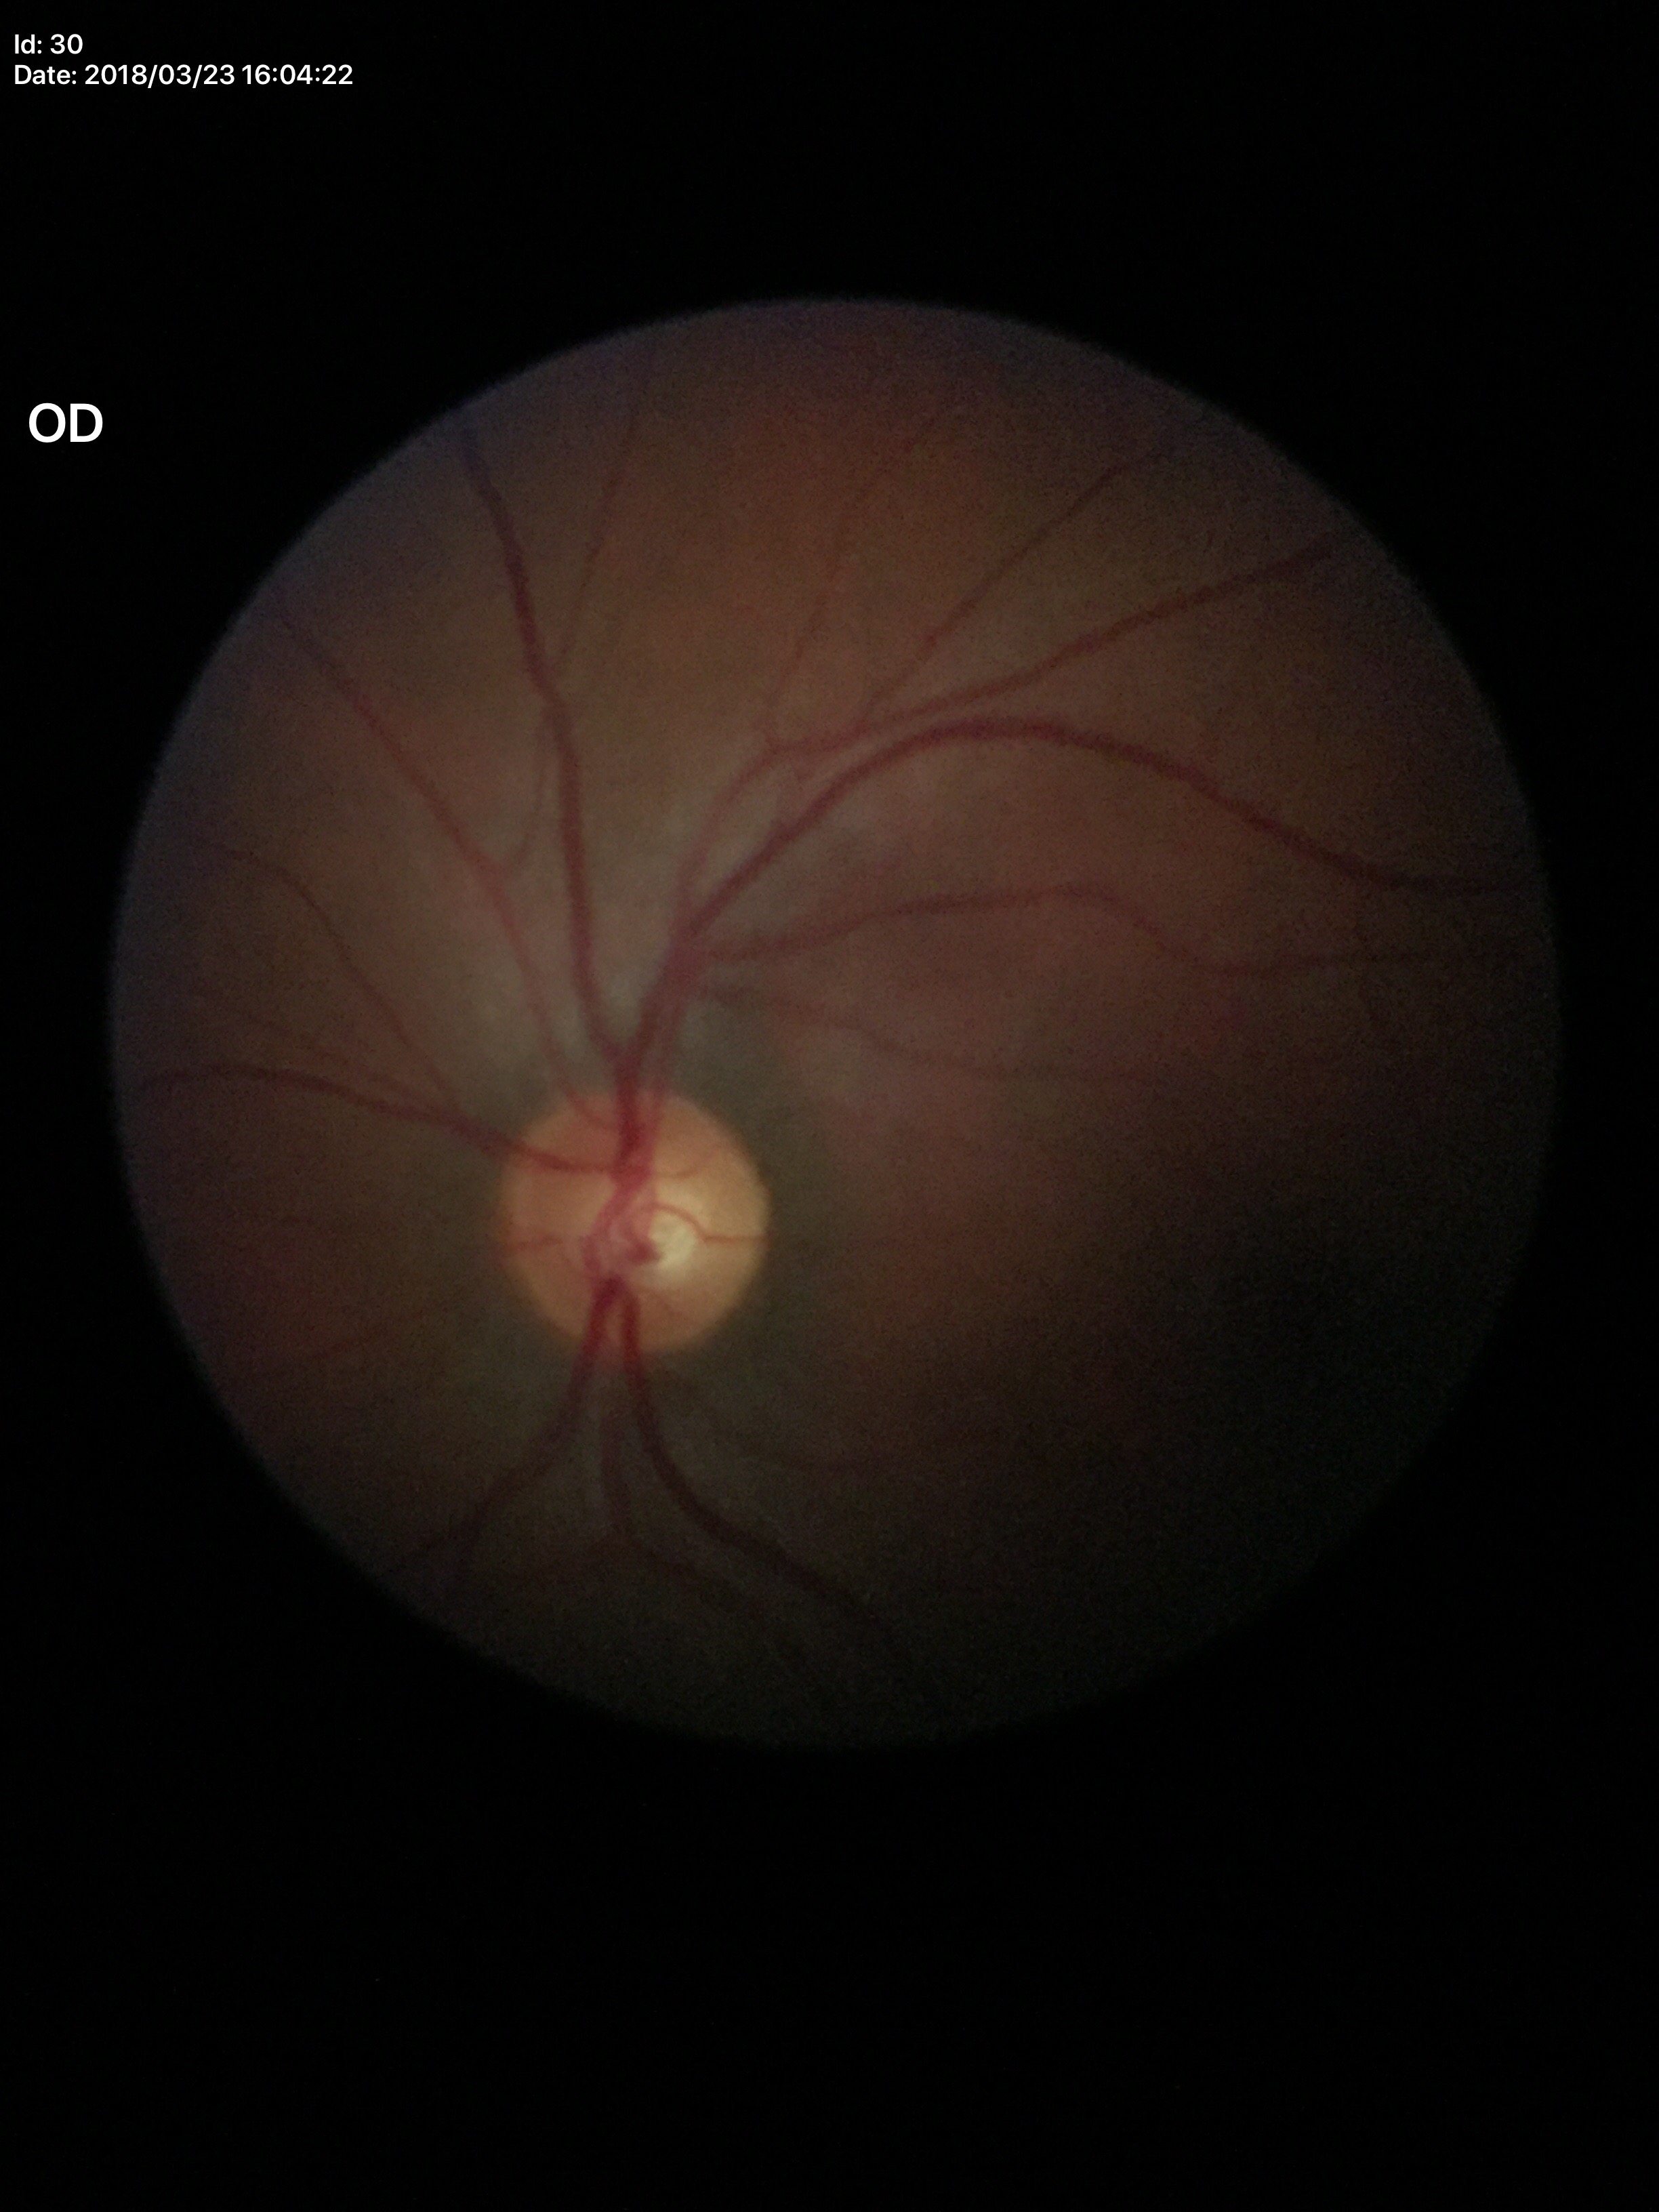

{"vcdr": "0.51", "glaucoma_decision": "no suspicious findings (unanimous normal call)", "hcdr": "0.52", "acdr": "0.27"}